CFP. 848x848: 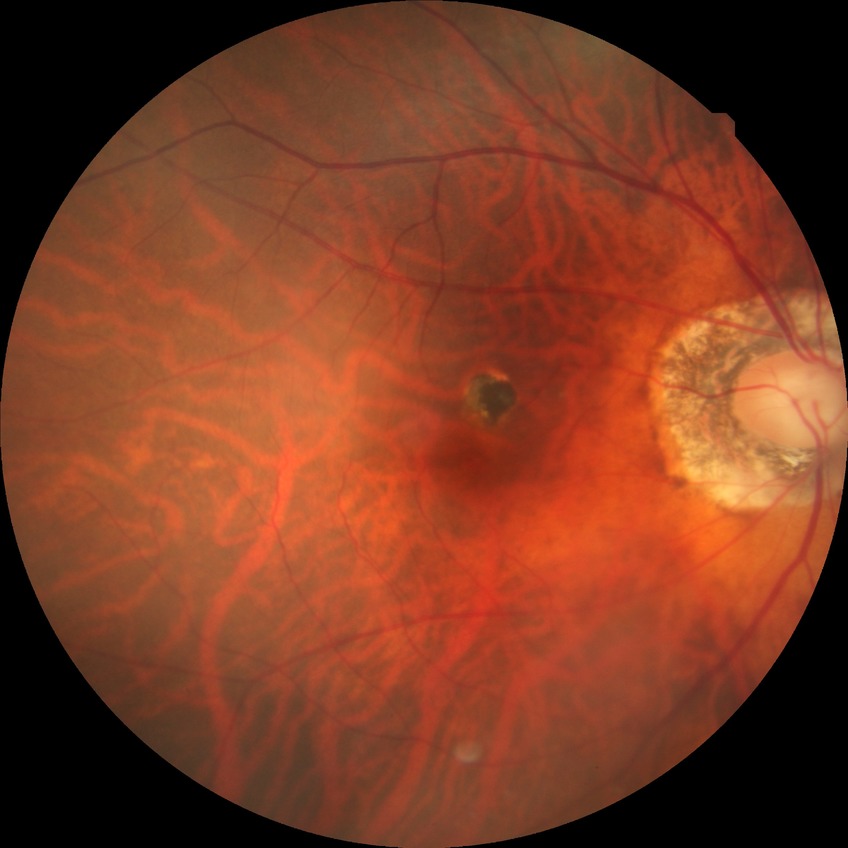 Diabetic retinopathy severity: no diabetic retinopathy.